Pupil-dilated; 50° field of view; color fundus image: 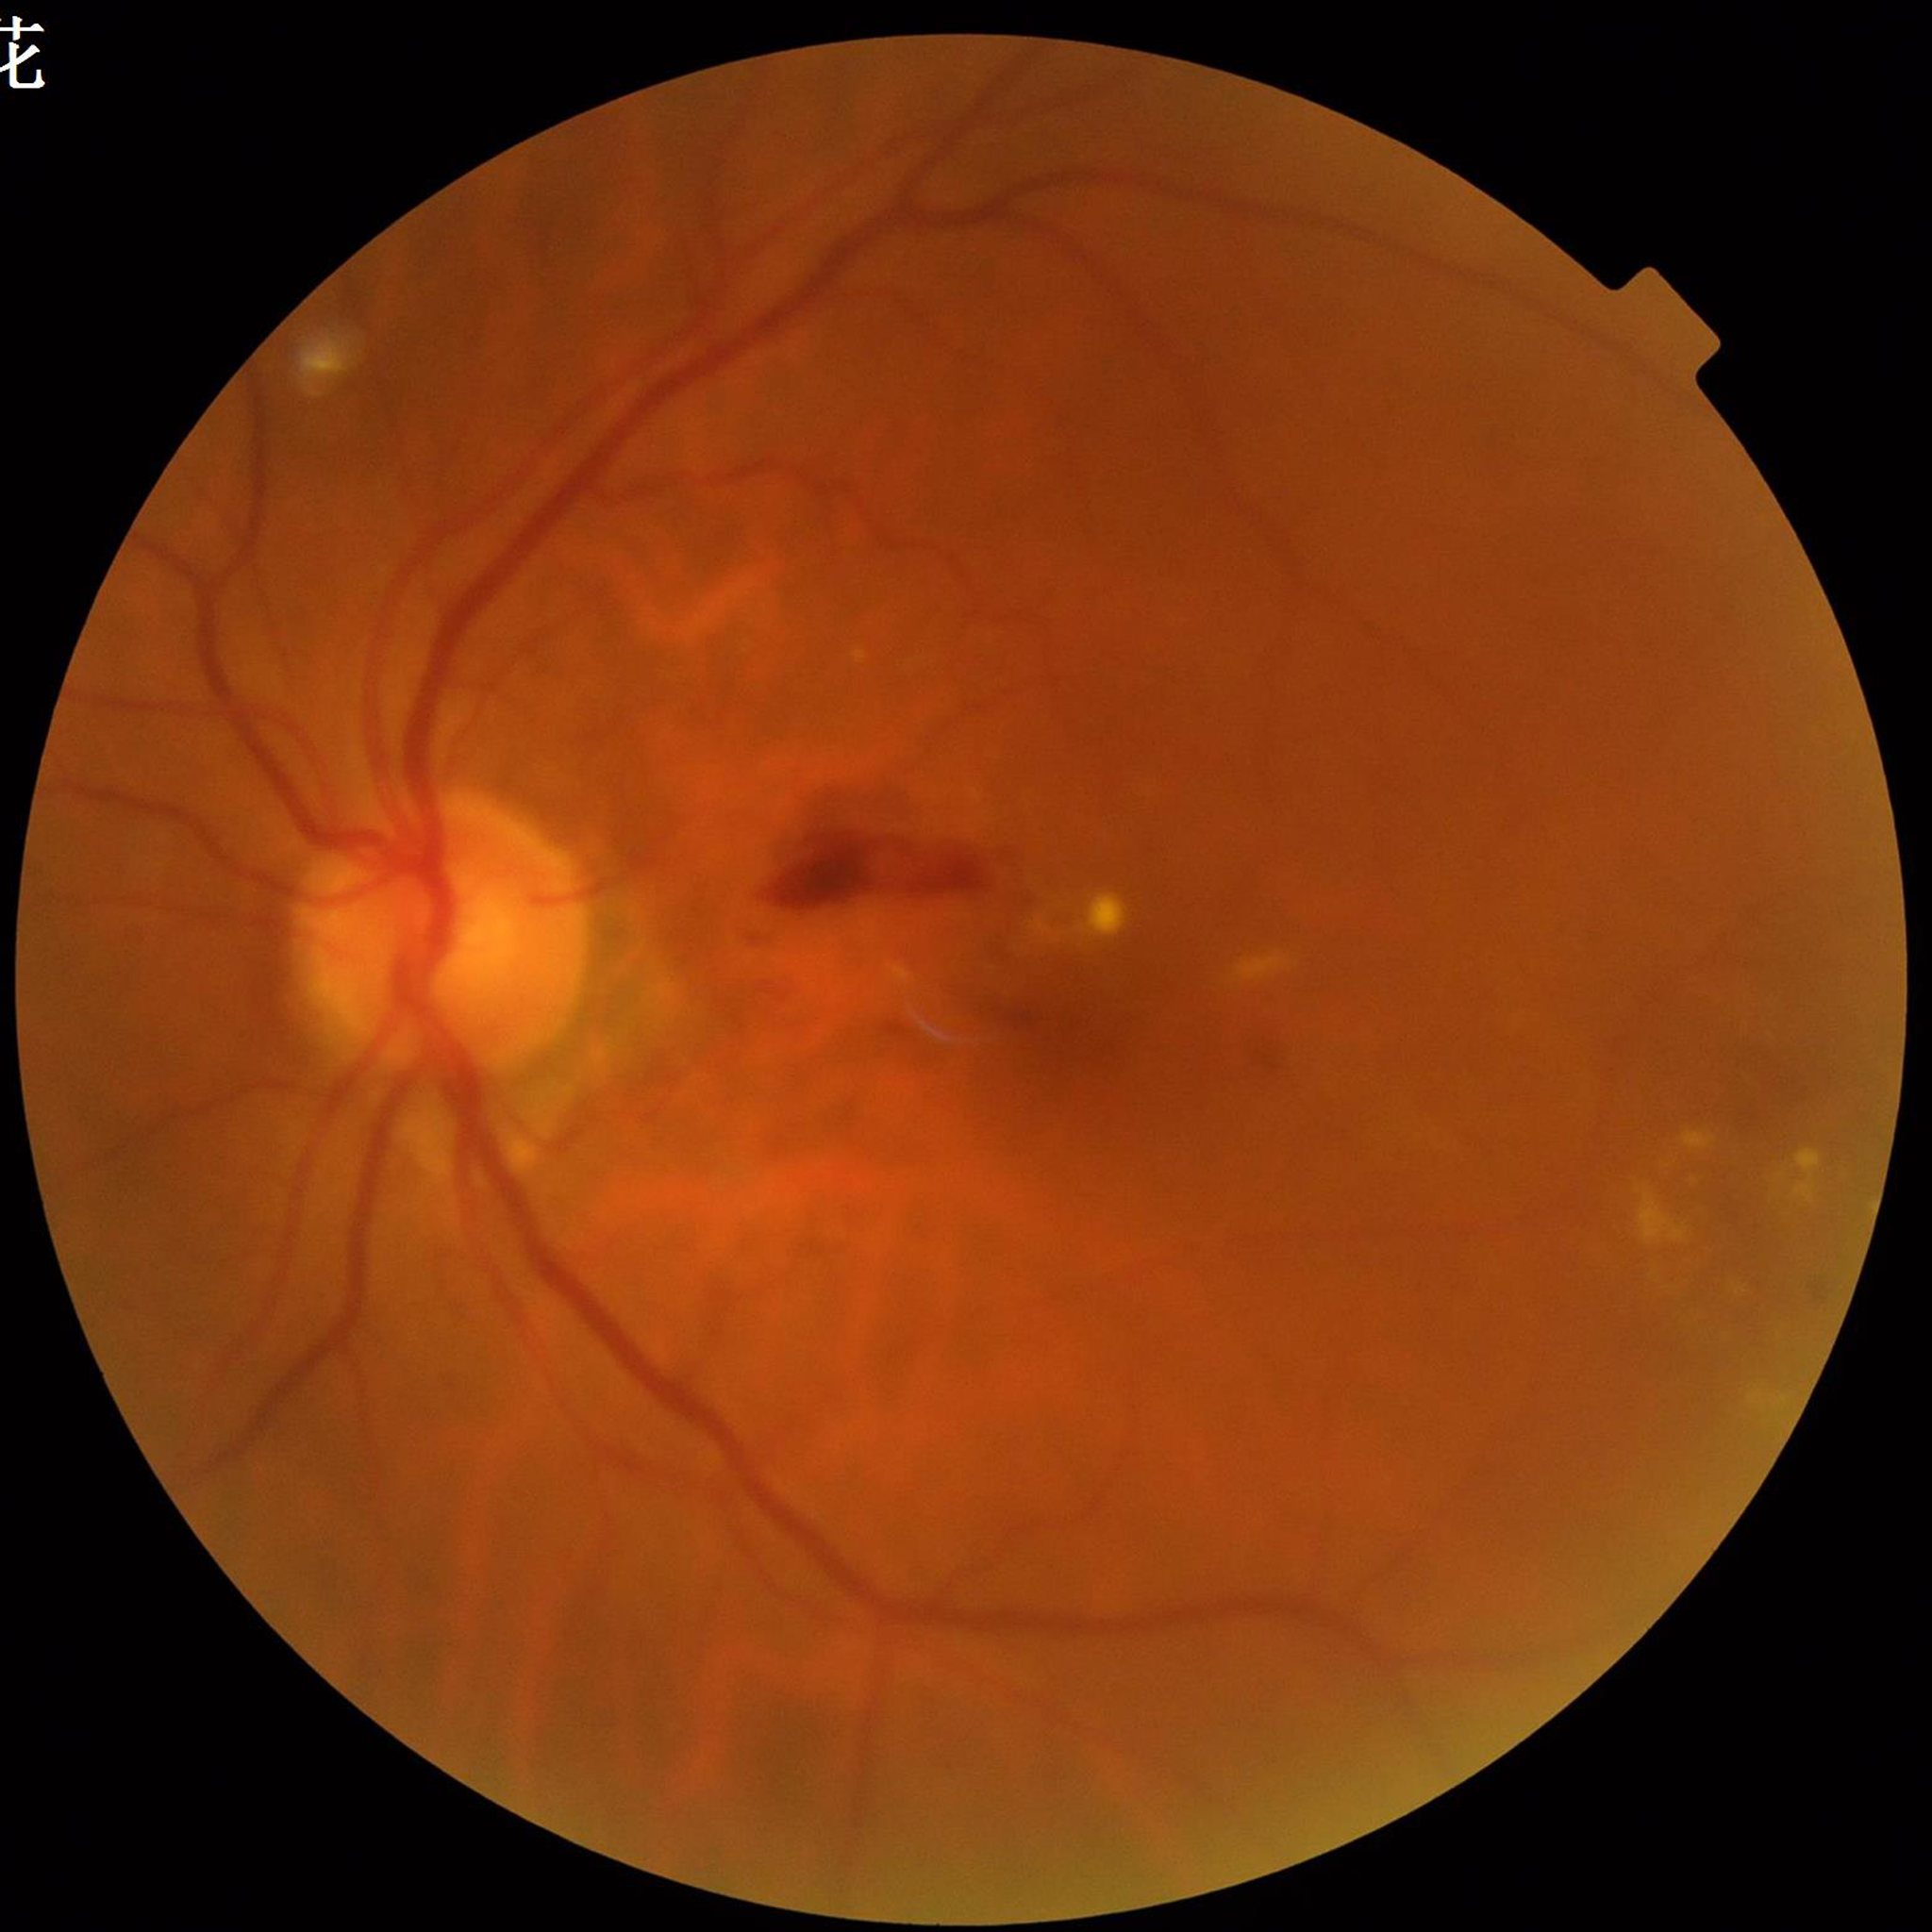
Diagnosis = DR | Automated quality assessment = poor — blur.